Optic disc photograph:
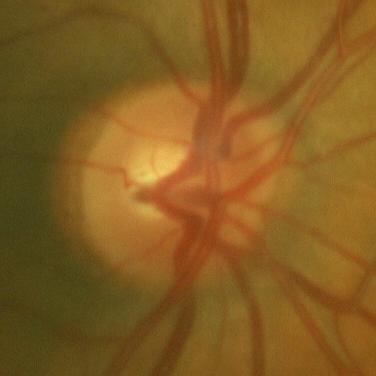 No glaucomatous changes.